Infant wide-field retinal image: 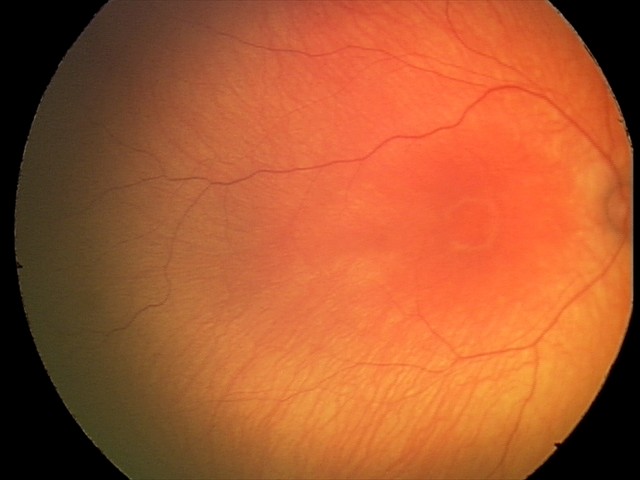
Screening examination with no abnormal retinal findings.